Camera: NIDEK AFC-230, nonmydriatic fundus photograph, 45 degree fundus photograph, posterior pole color fundus photograph, 848x848px:
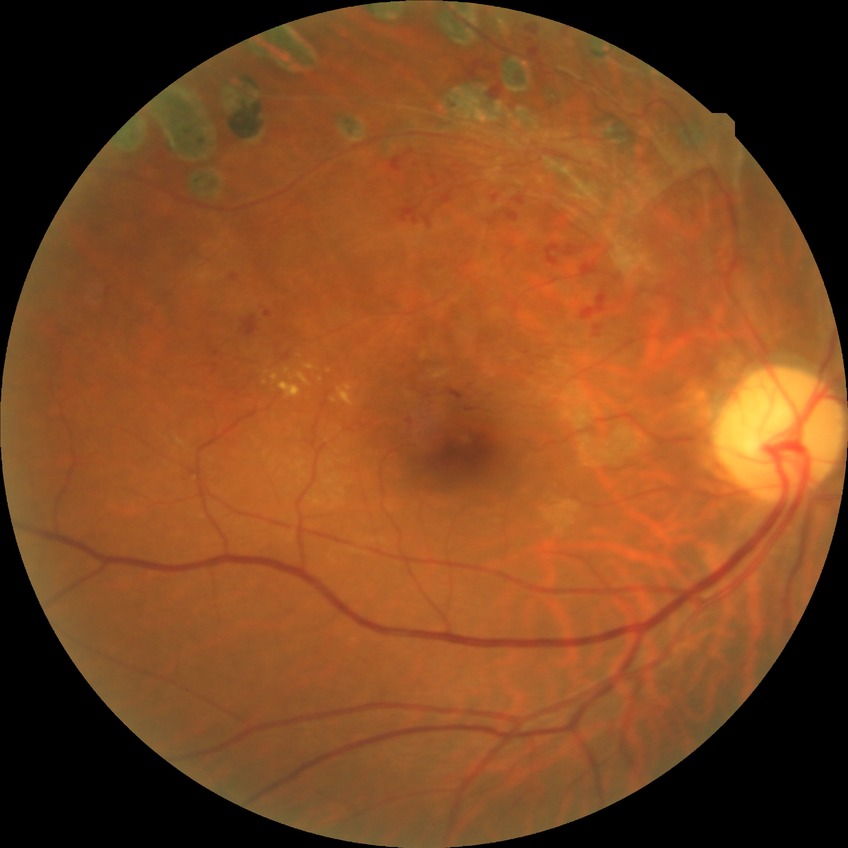 Diabetic retinopathy (DR): NDR (no diabetic retinopathy).